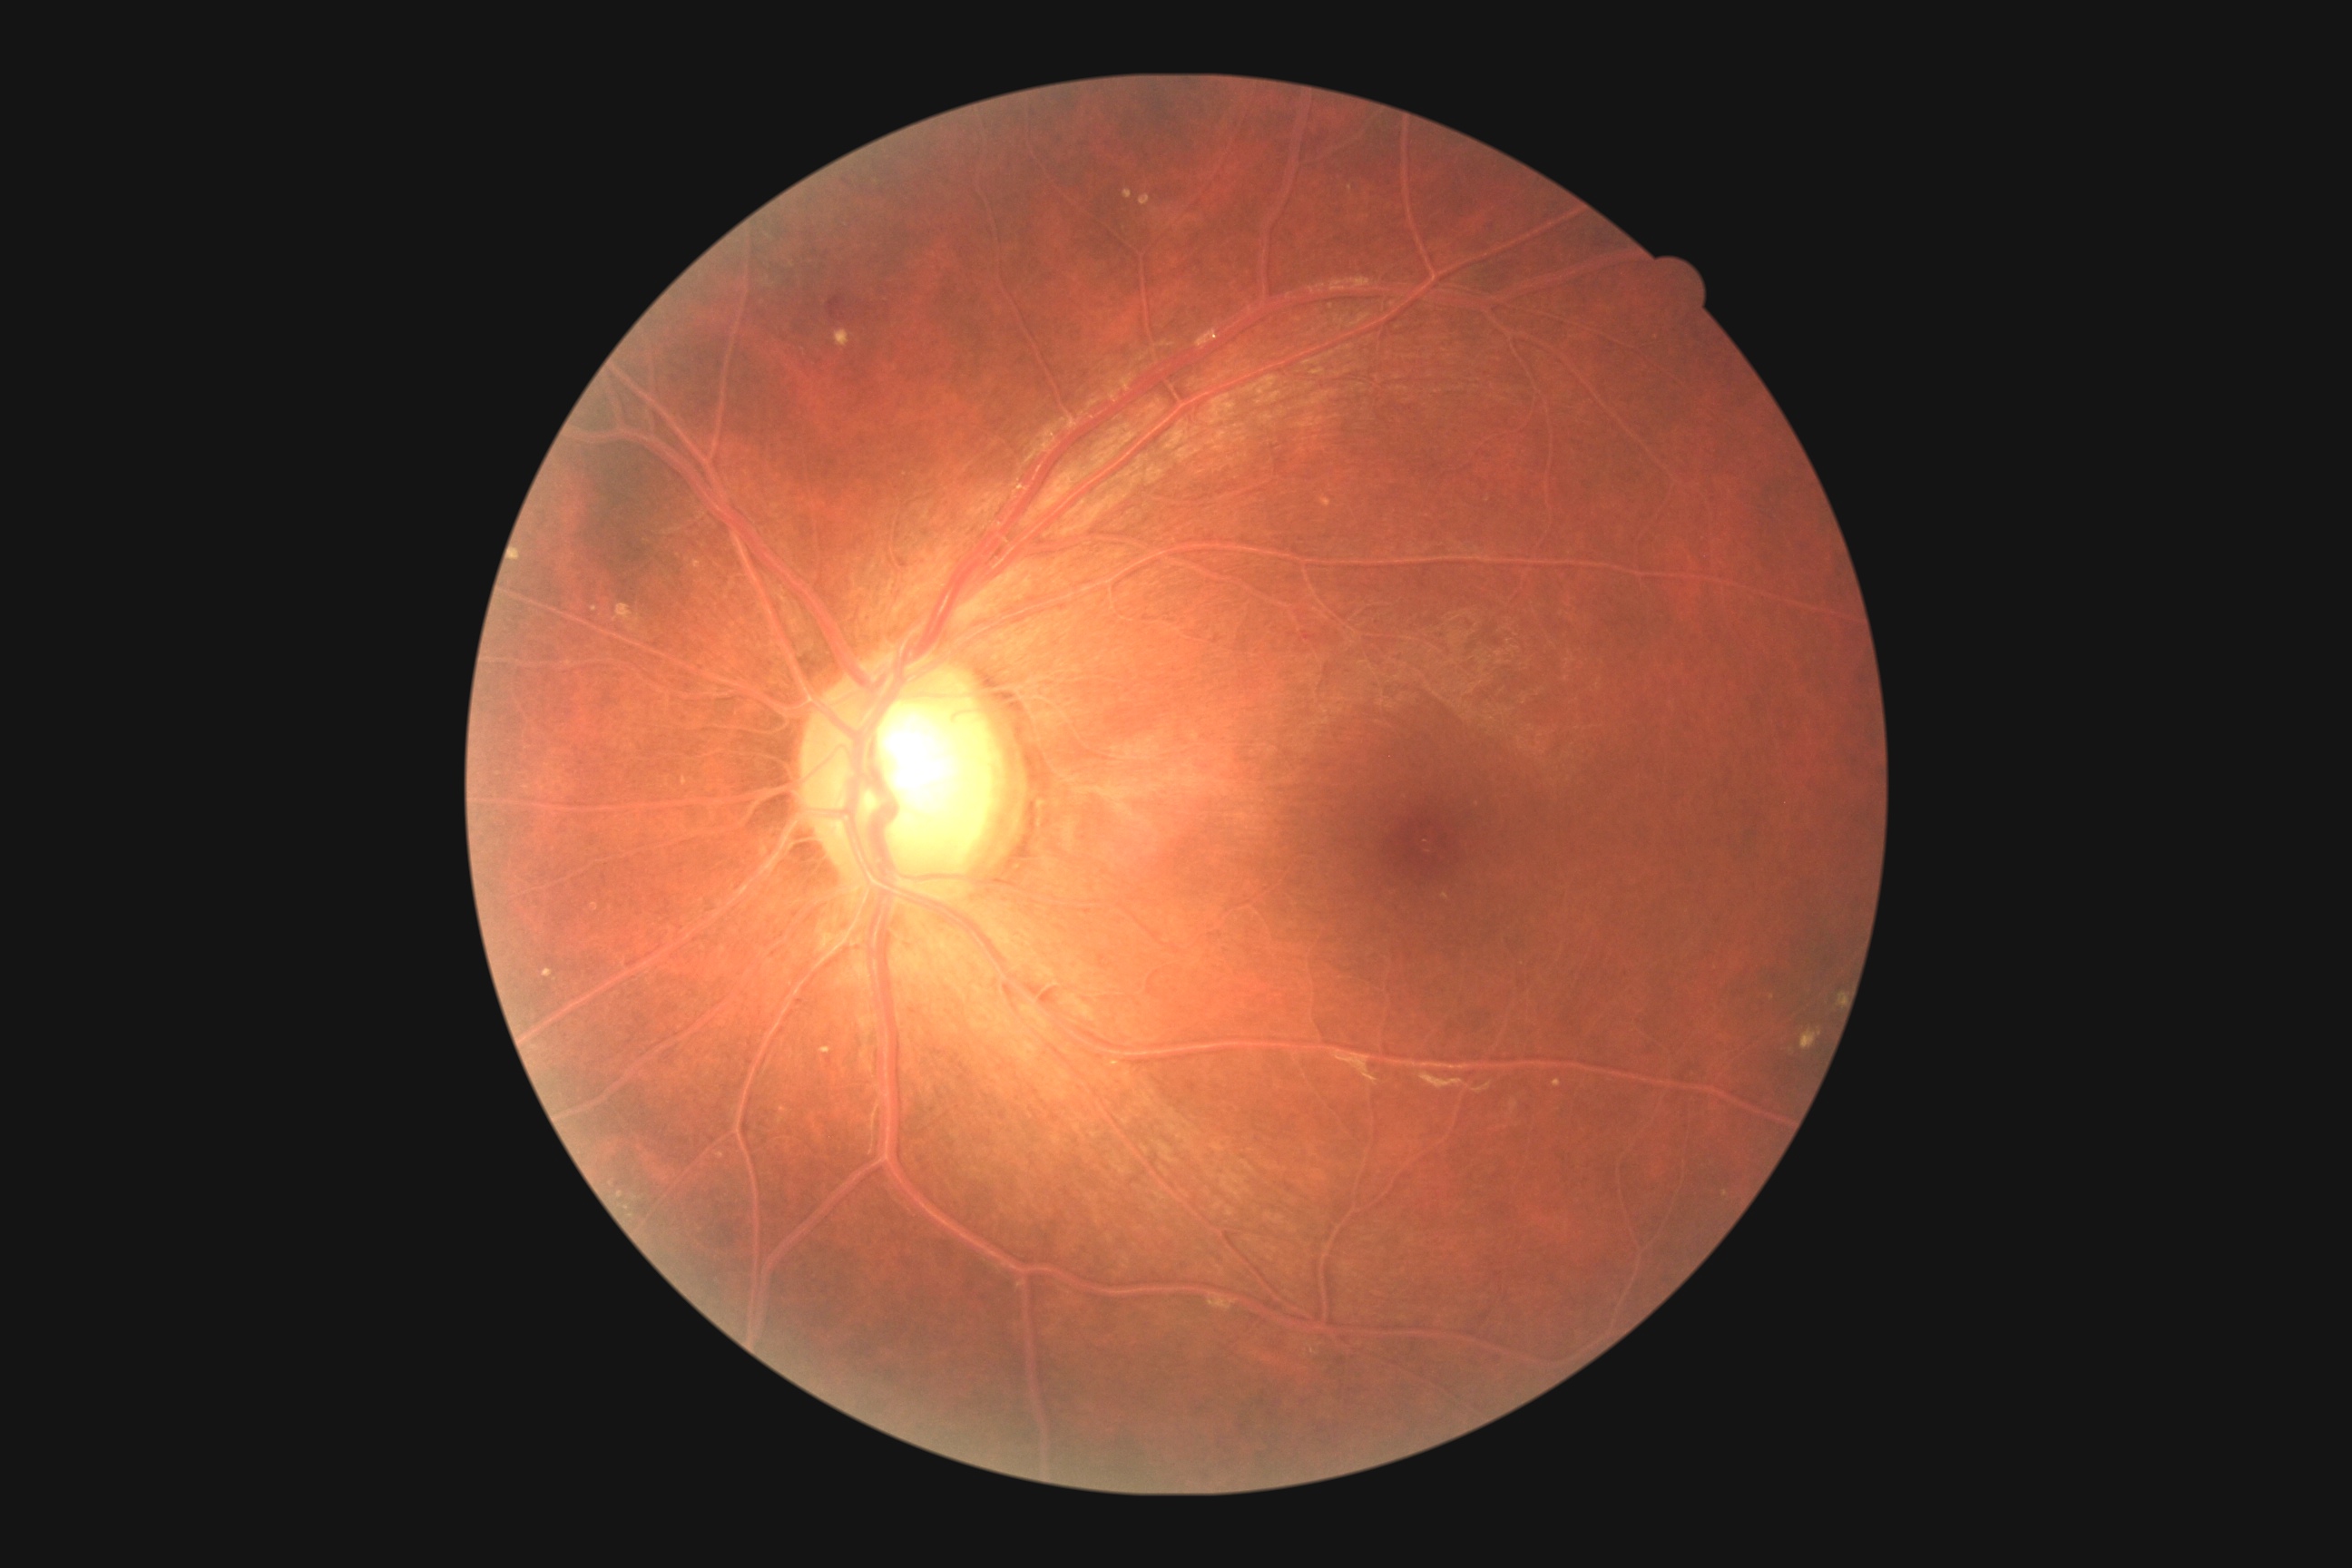
retinopathy grade: moderate NPDR (2).